Portable fundus camera image:
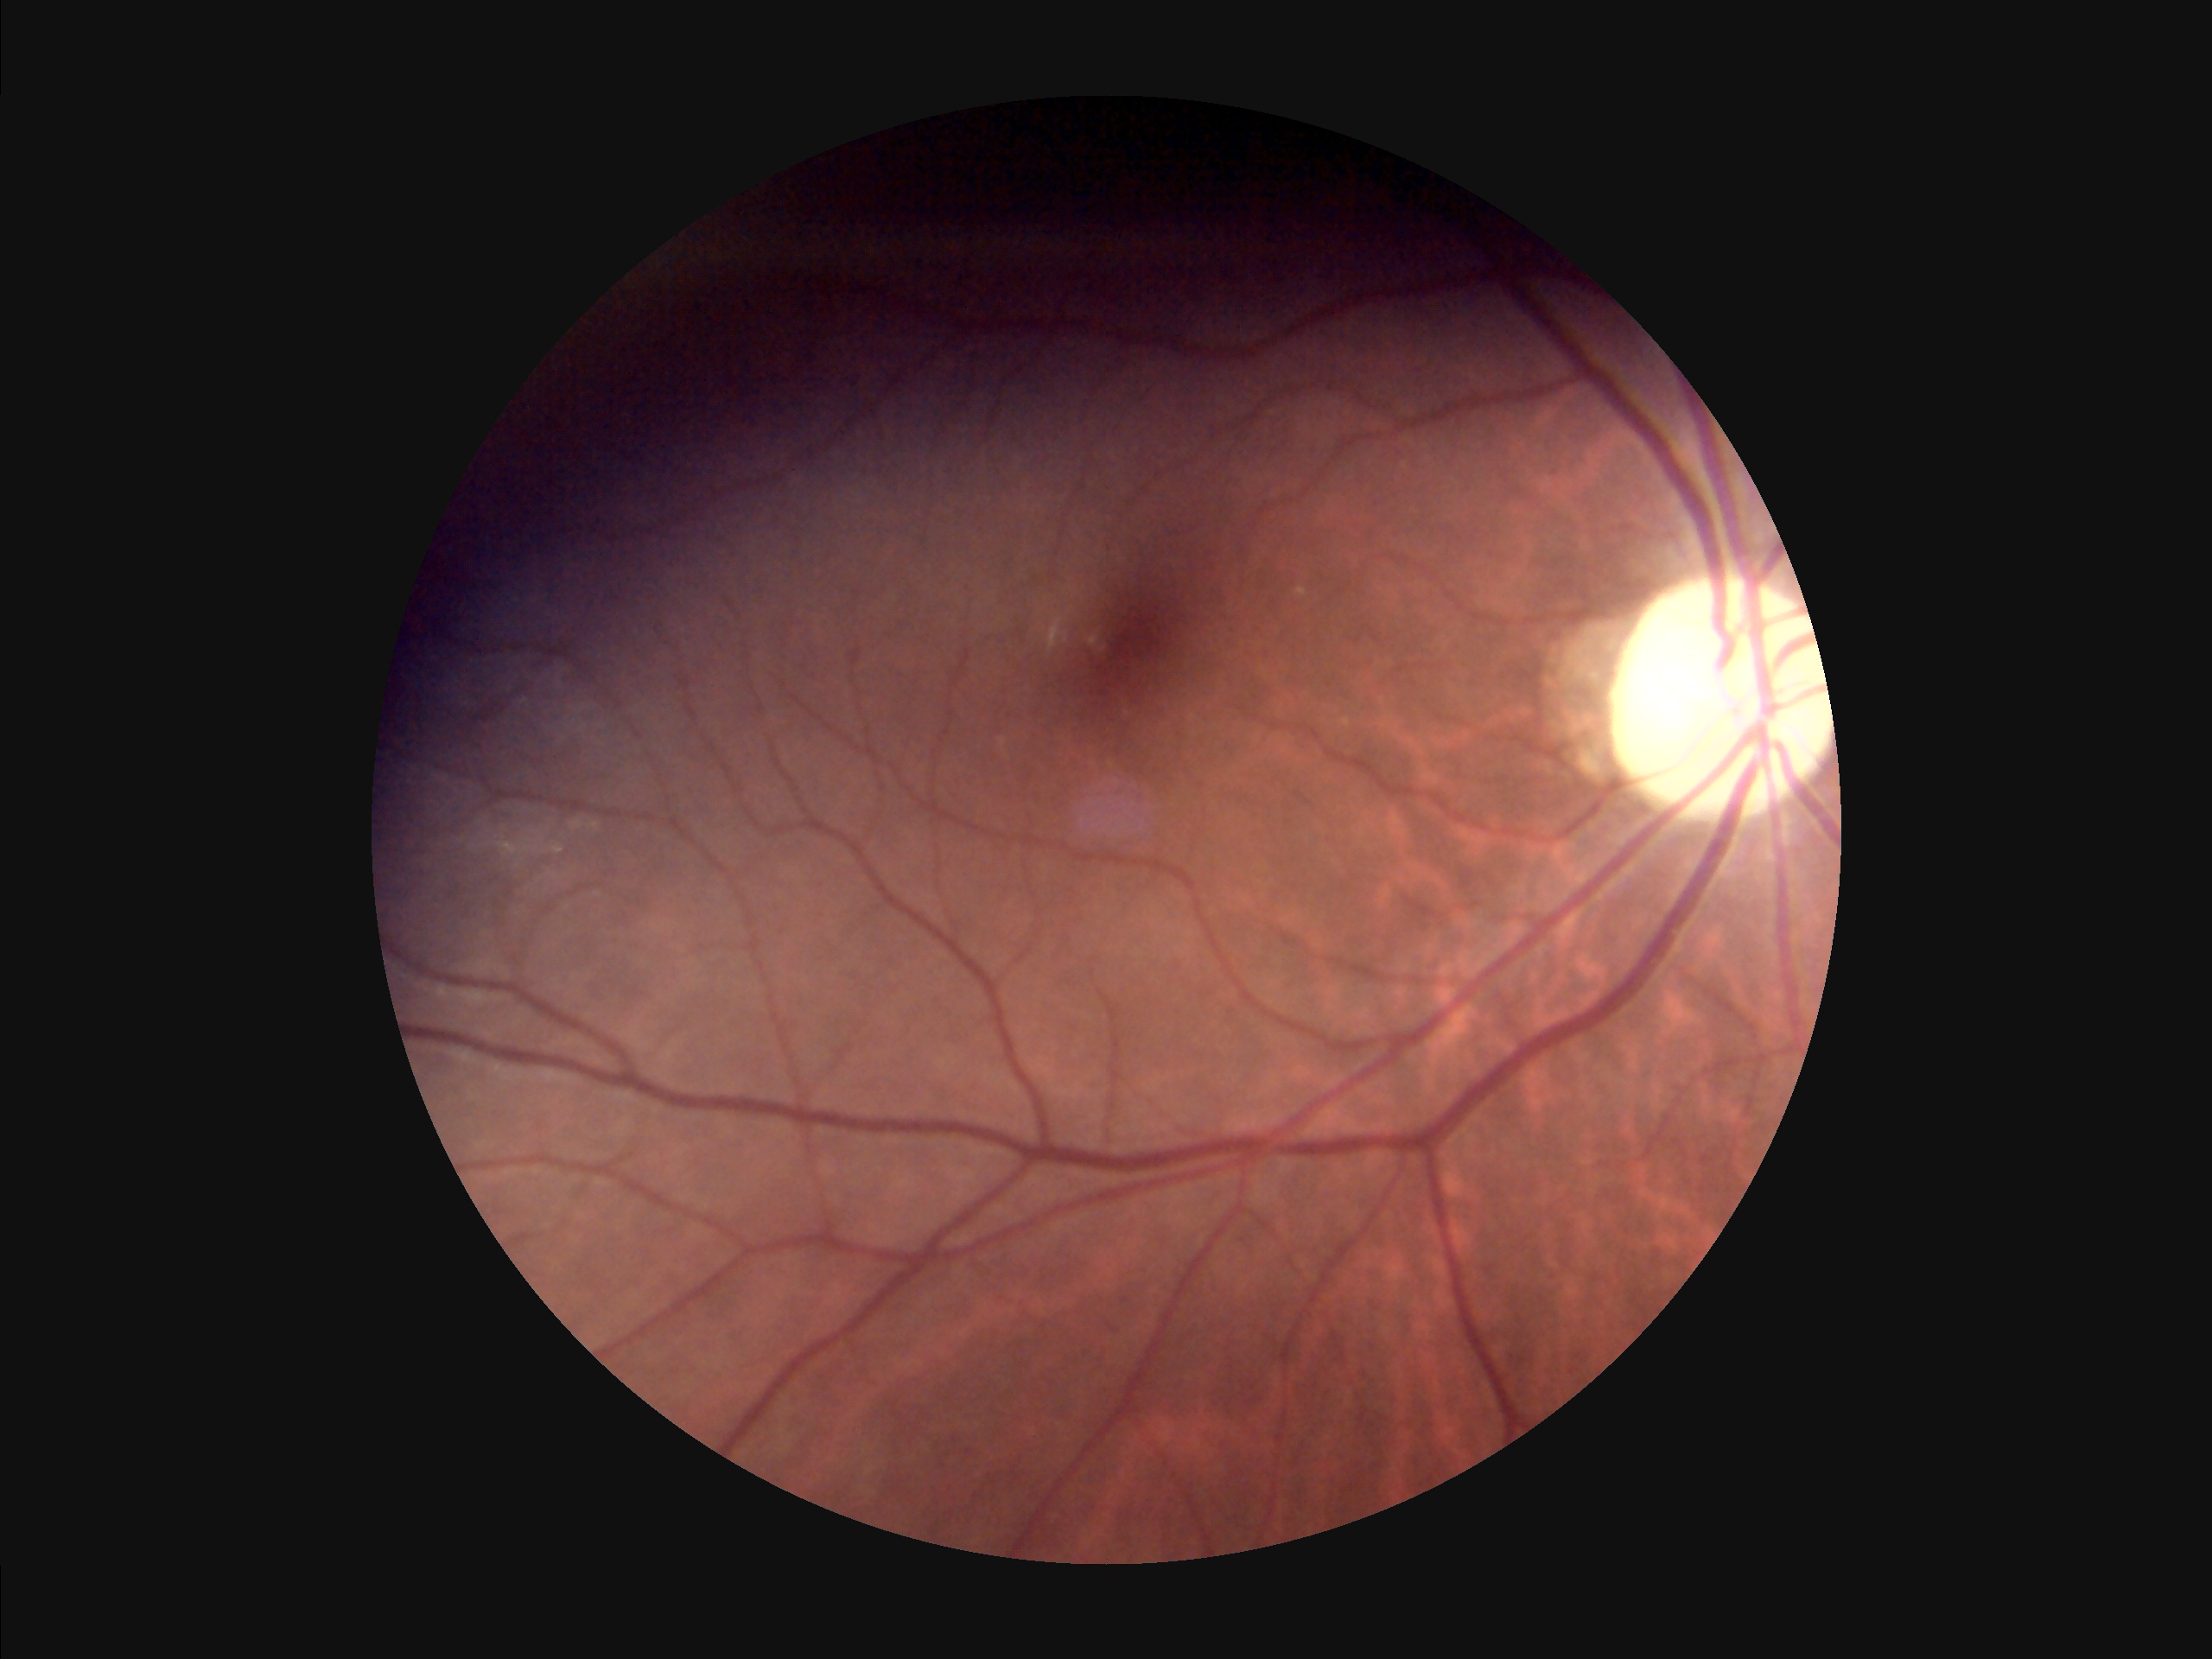
There is over- or under-exposure or a color cast.
The image is clear.
Image quality is inadequate for diagnostic use.
Adequate contrast for distinguishing structures.